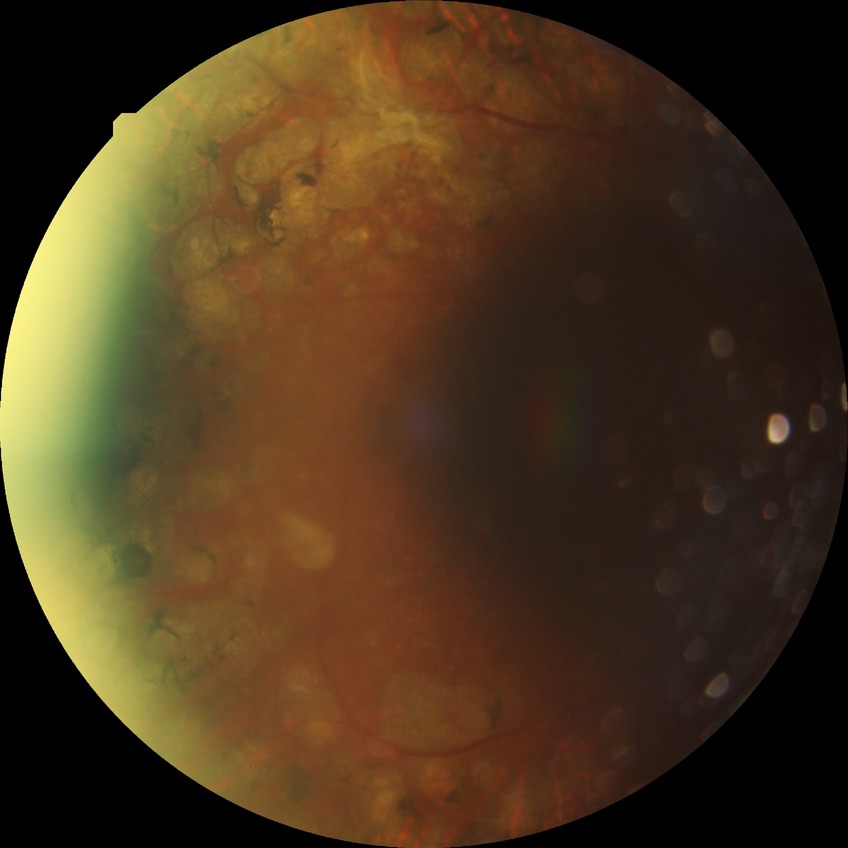

Diabetic retinopathy (DR) is PDR (proliferative diabetic retinopathy).